Handheld portable fundus camera image; 2212 x 1659 pixels; 60° FOV
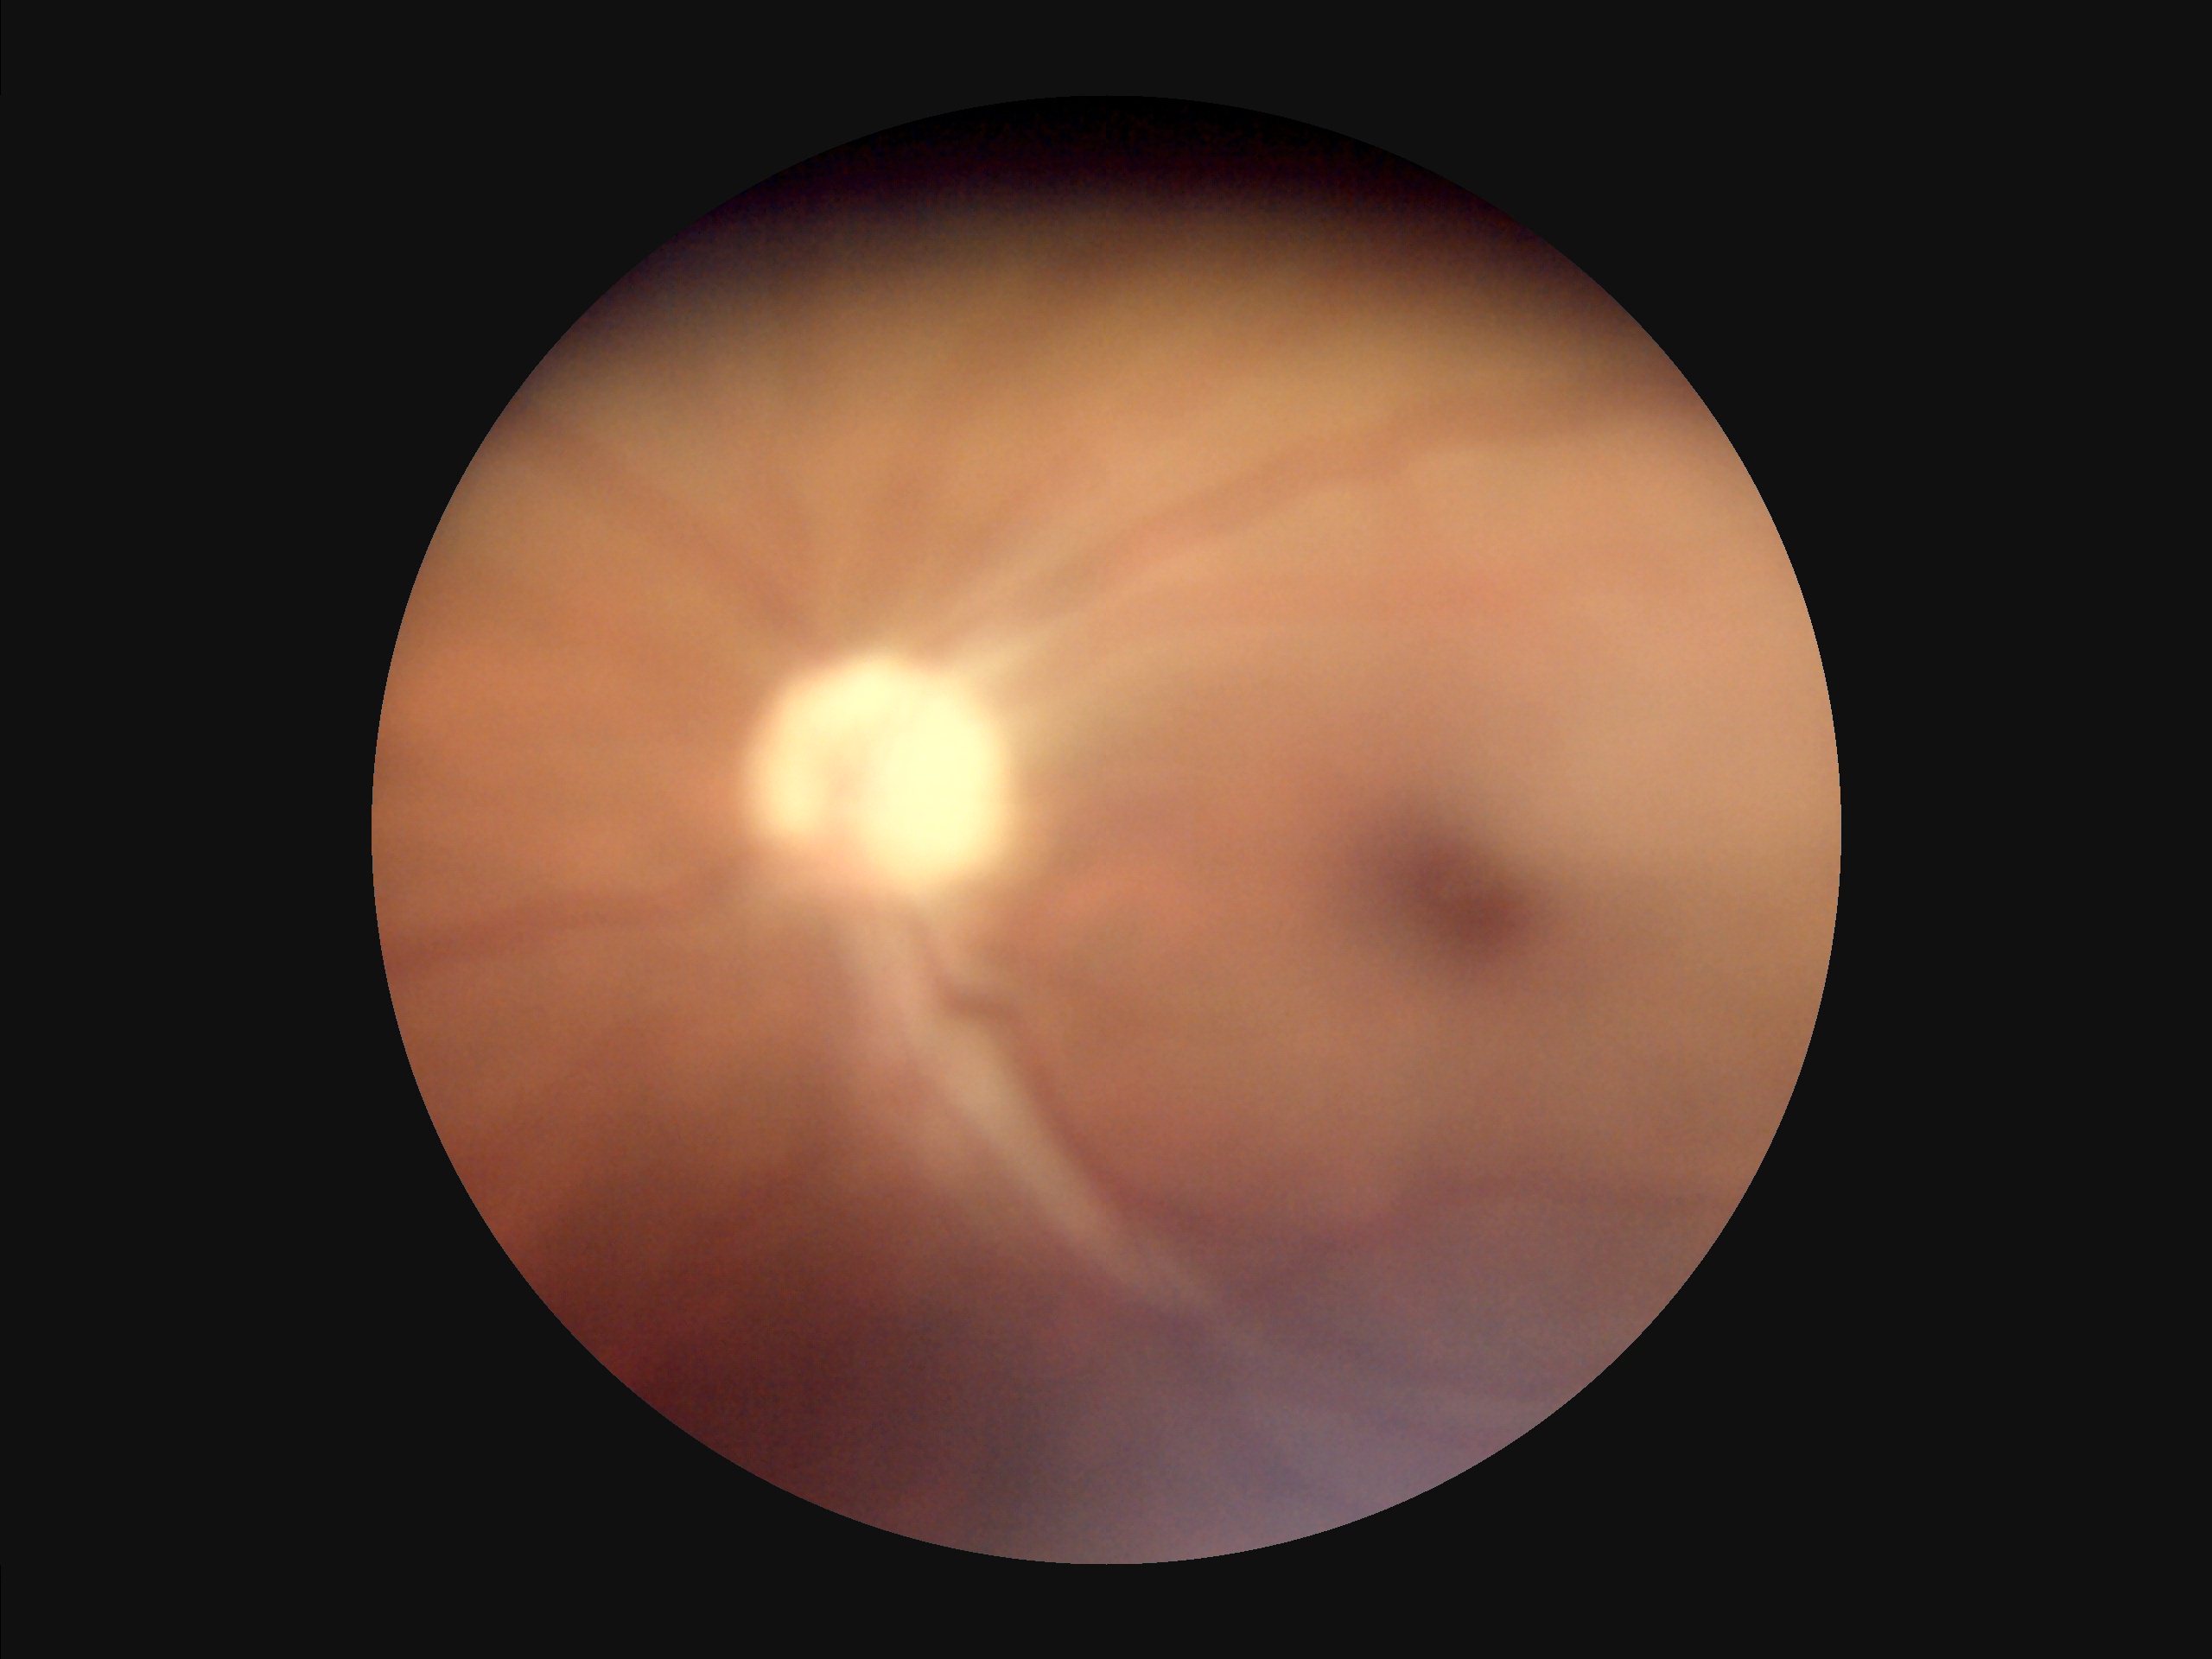 Illumination is uneven. The image is blurry. Poor dynamic range. Image quality is suboptimal.